848 by 848 pixels: 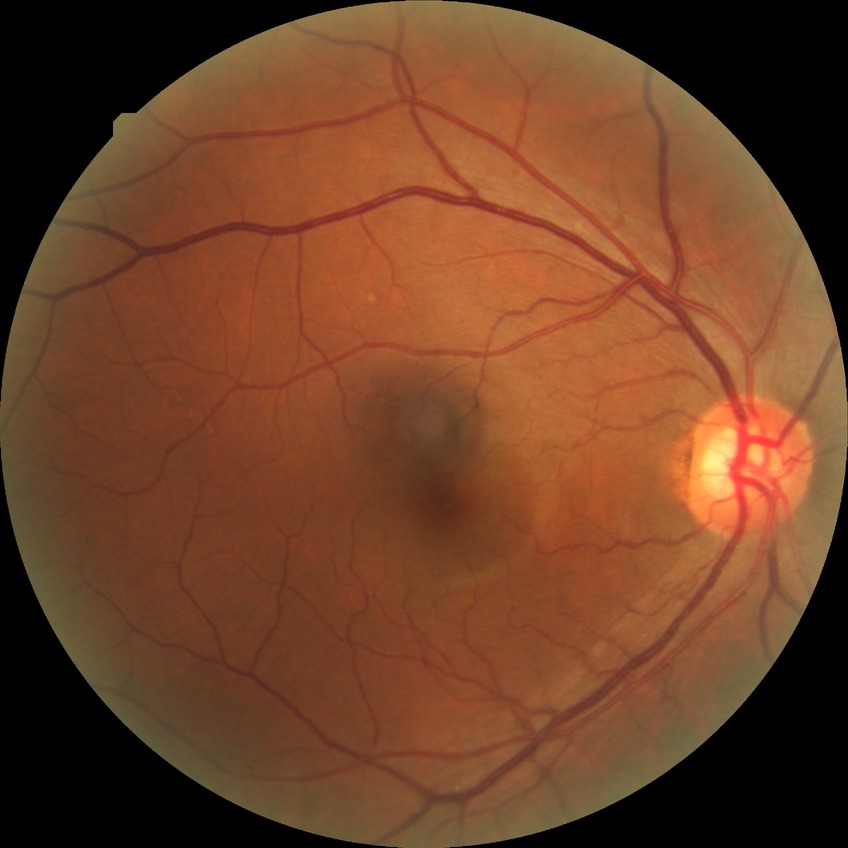

modified Davis classification=no diabetic retinopathy.